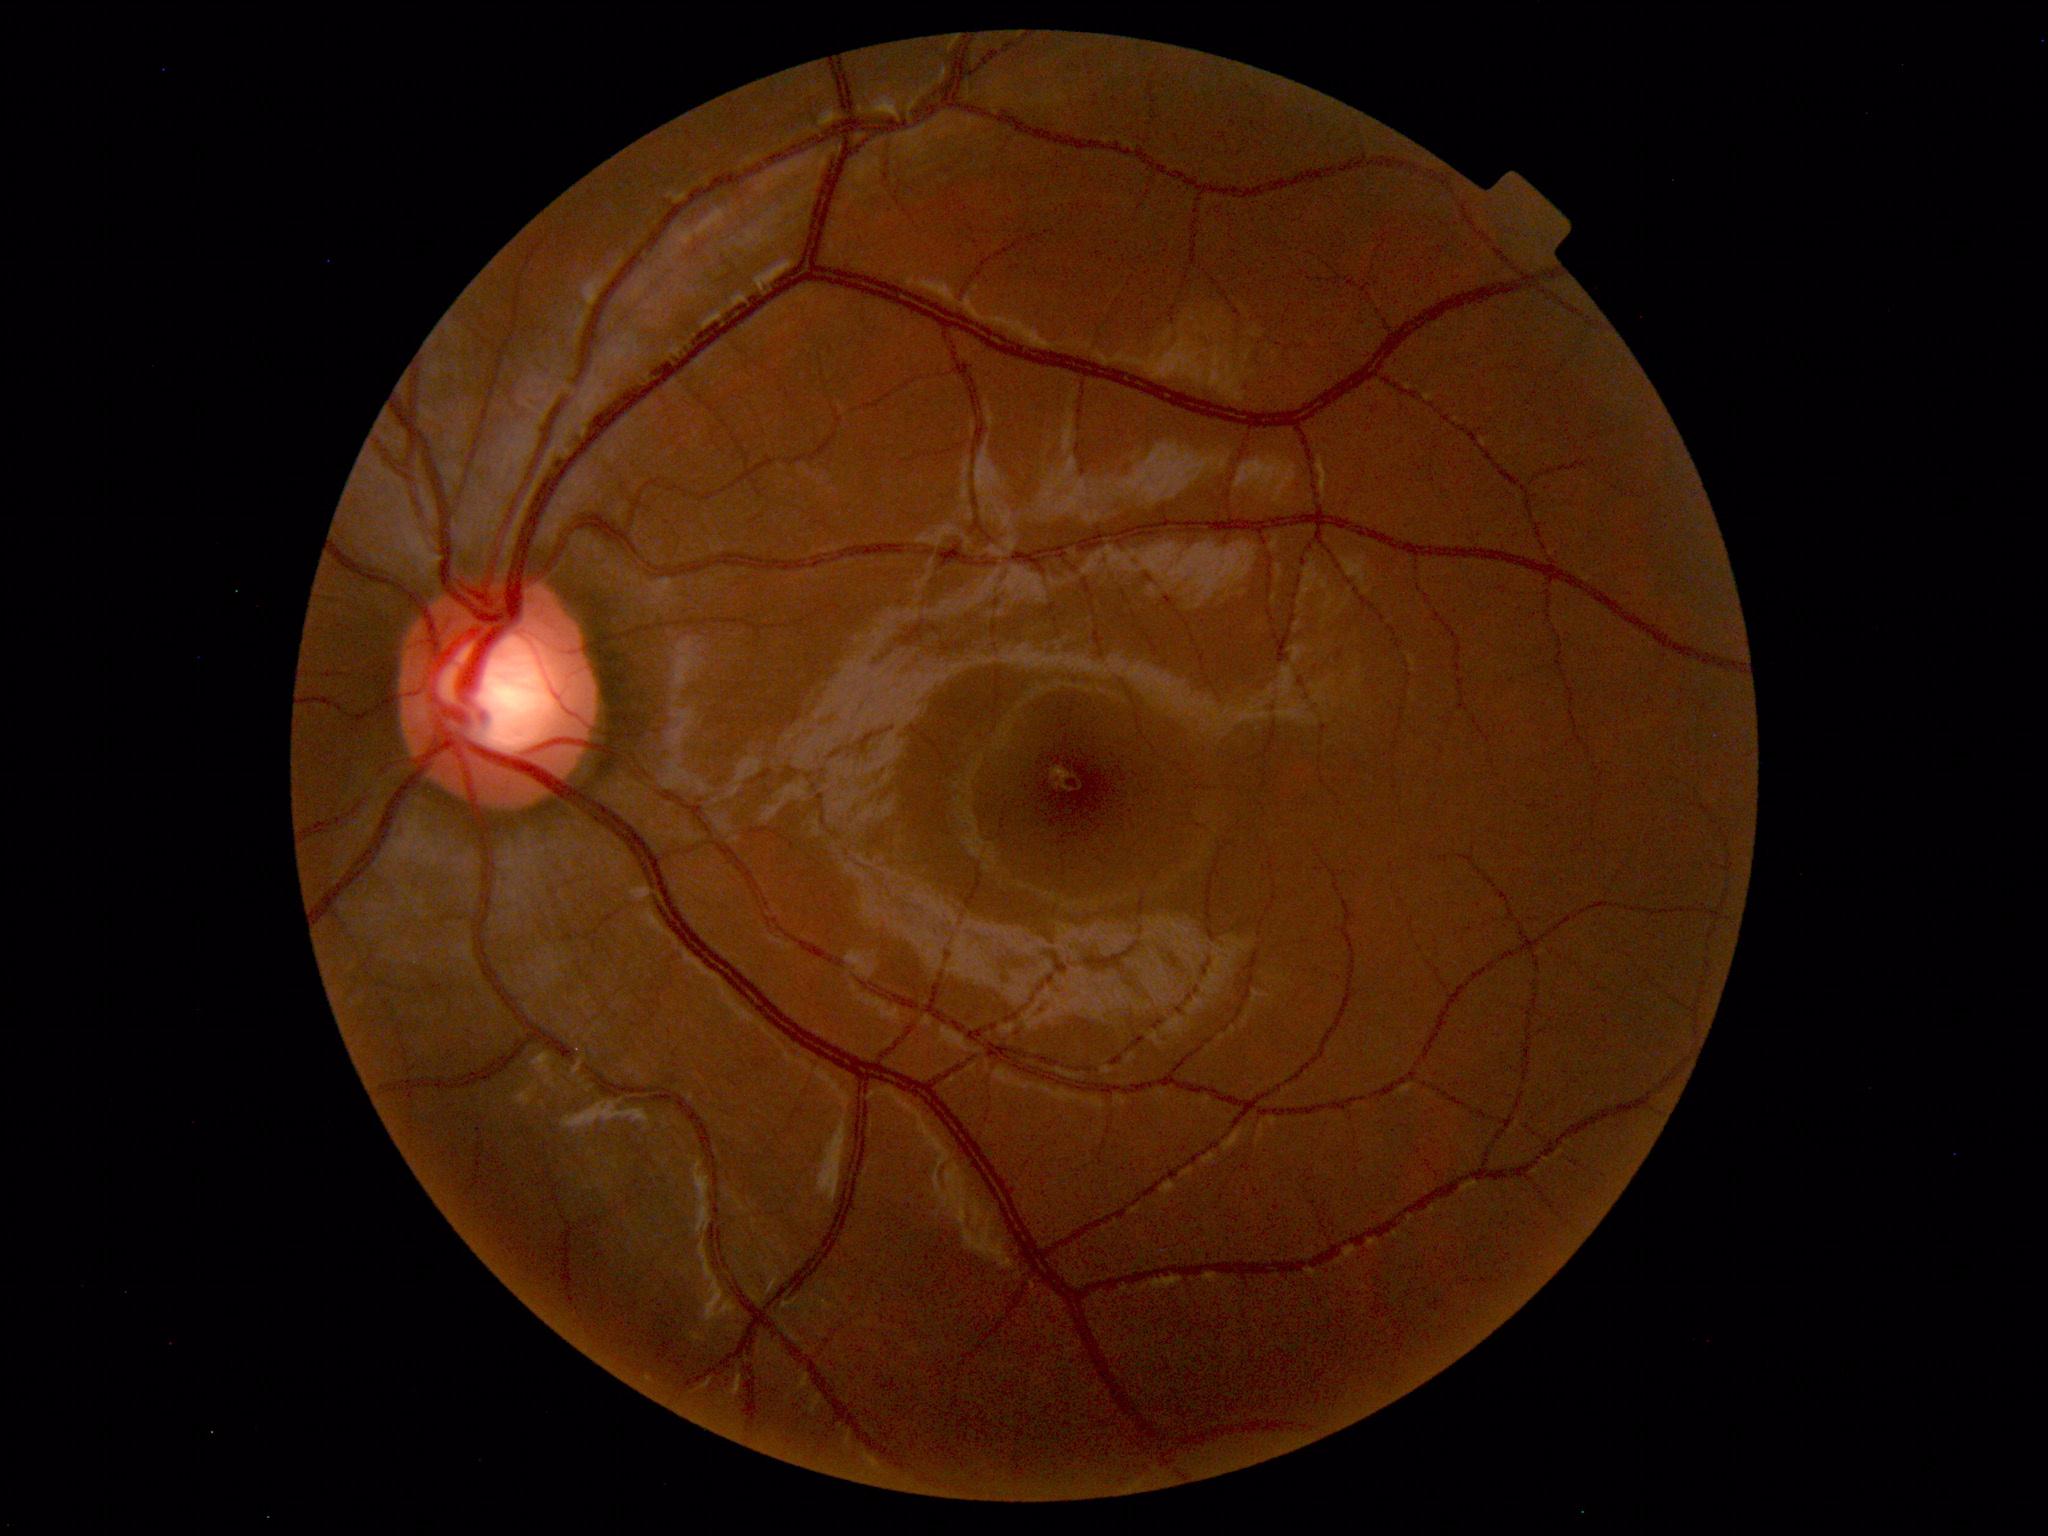
No retinal pathology identified.